Retinal fundus photograph.
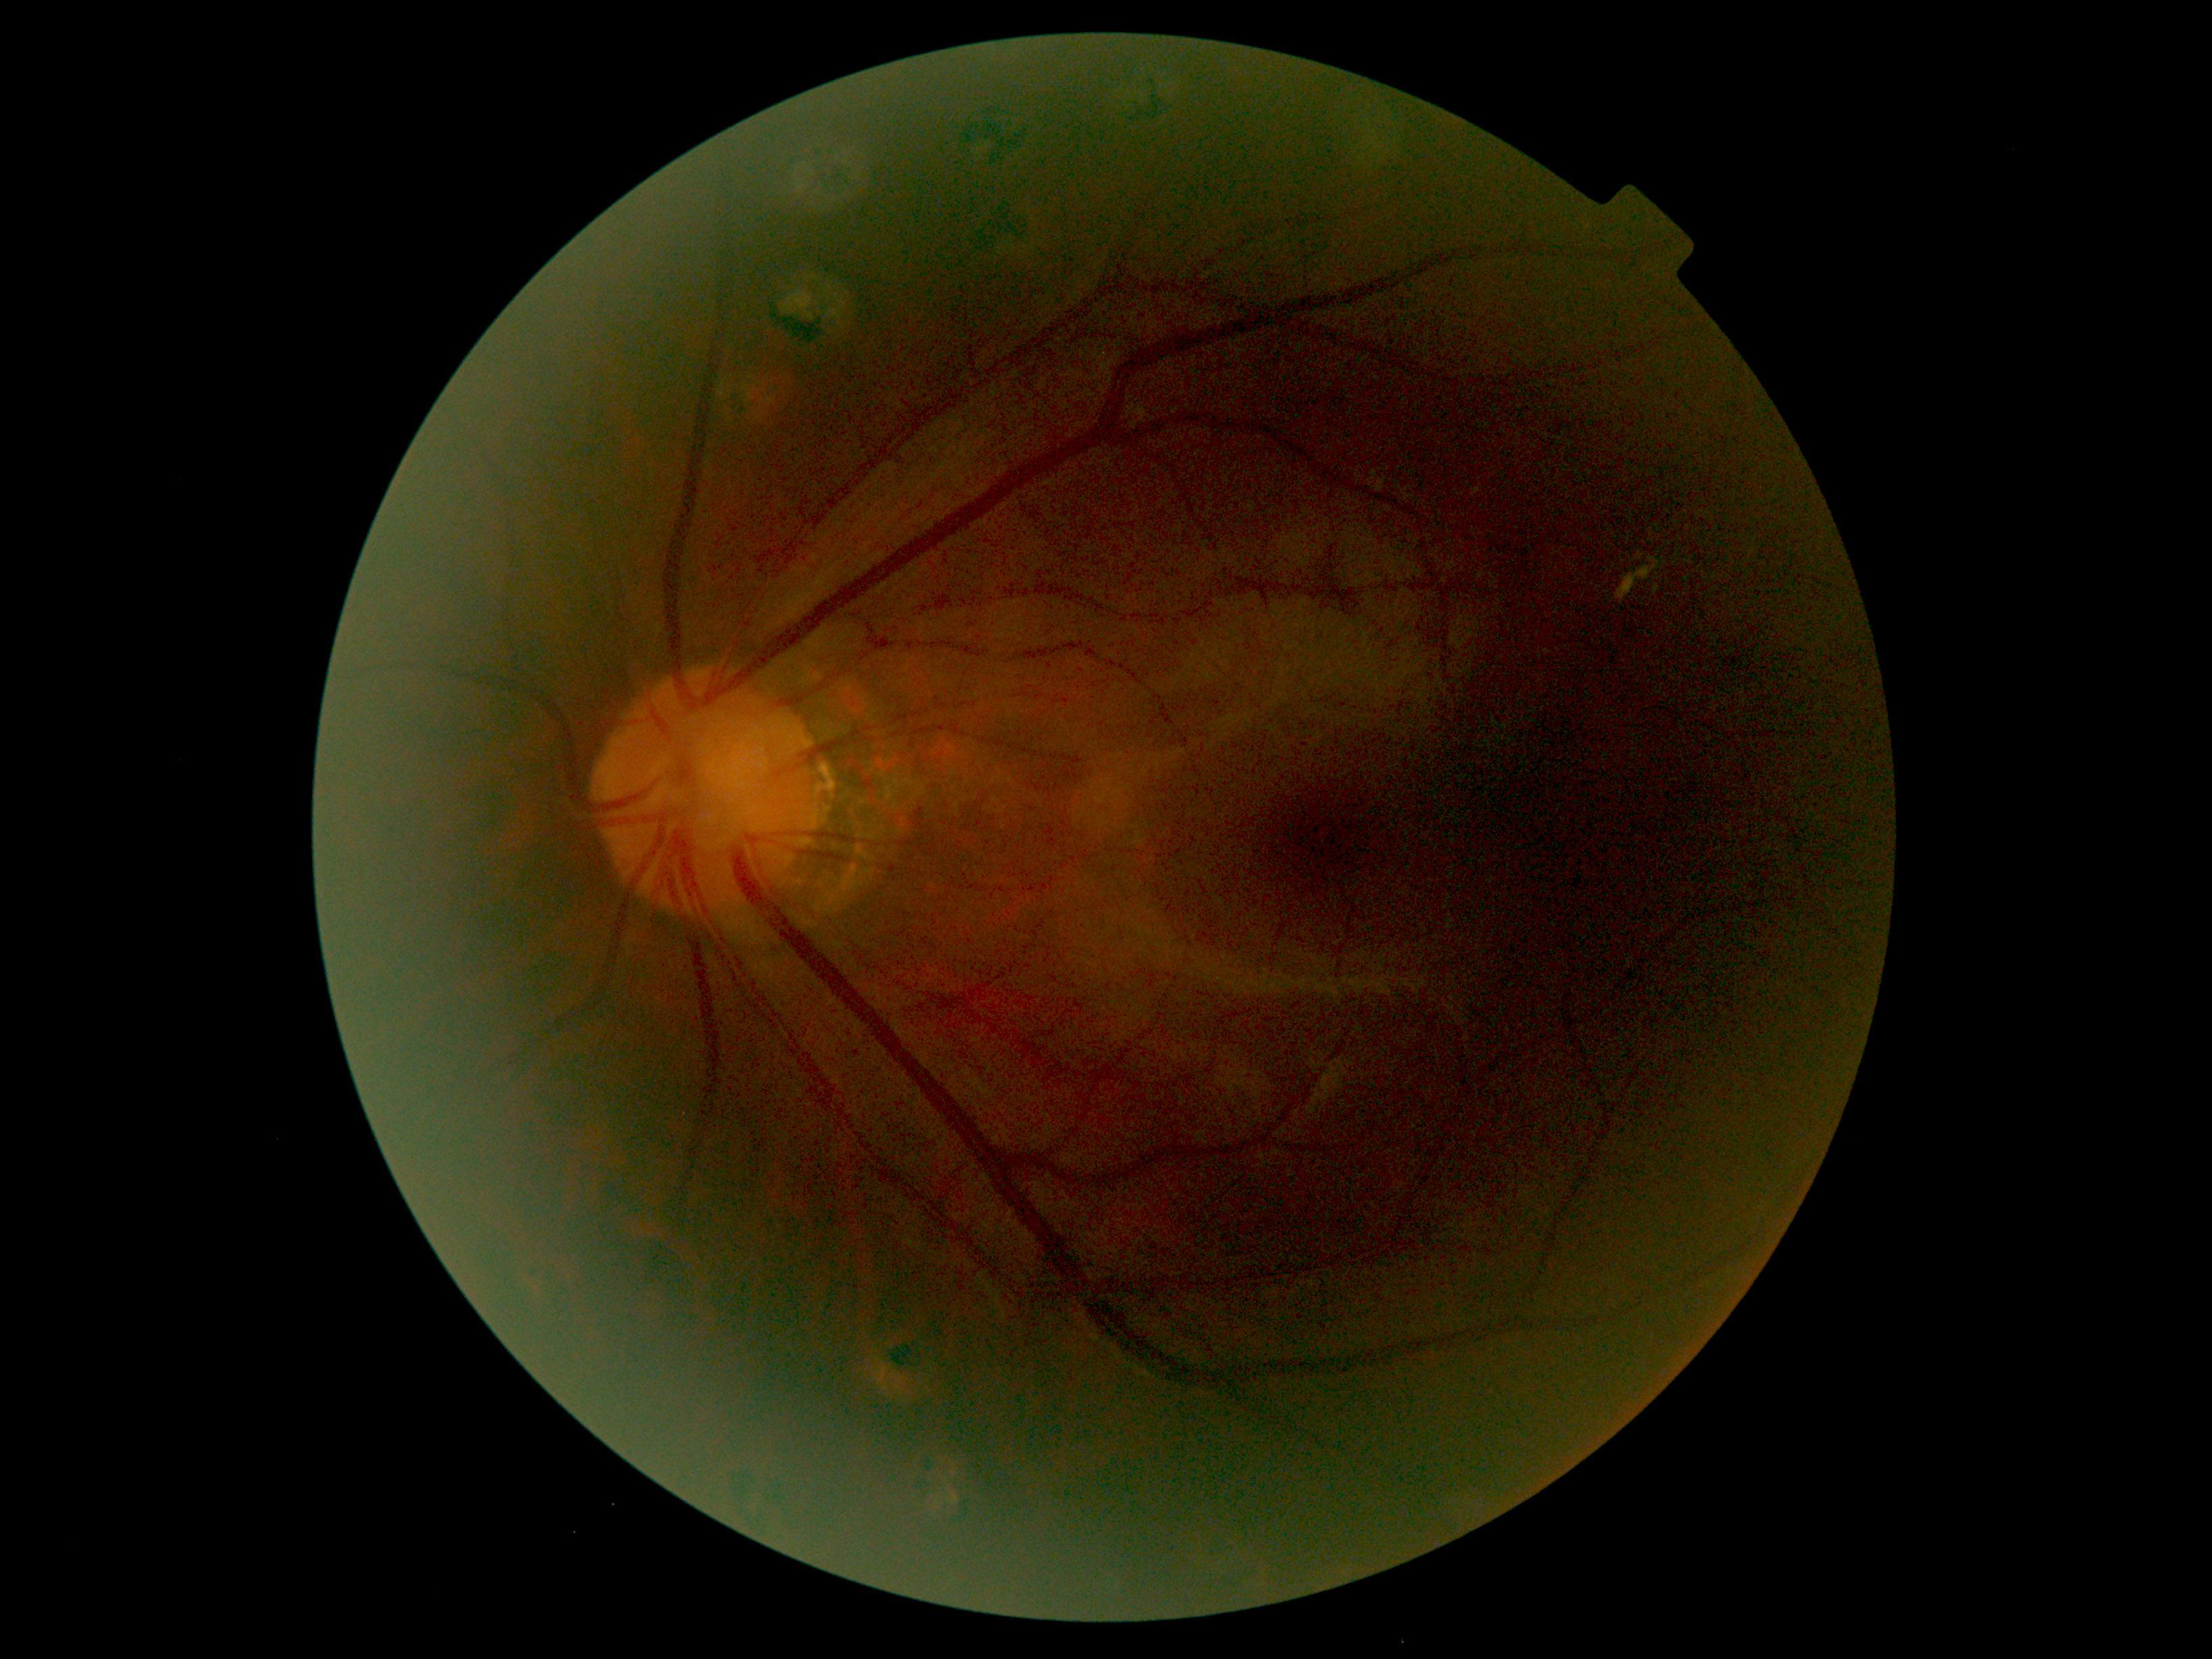
DR stage is grade 2 (moderate NPDR) — more than just microaneurysms but less than severe NPDR.